Color fundus image:
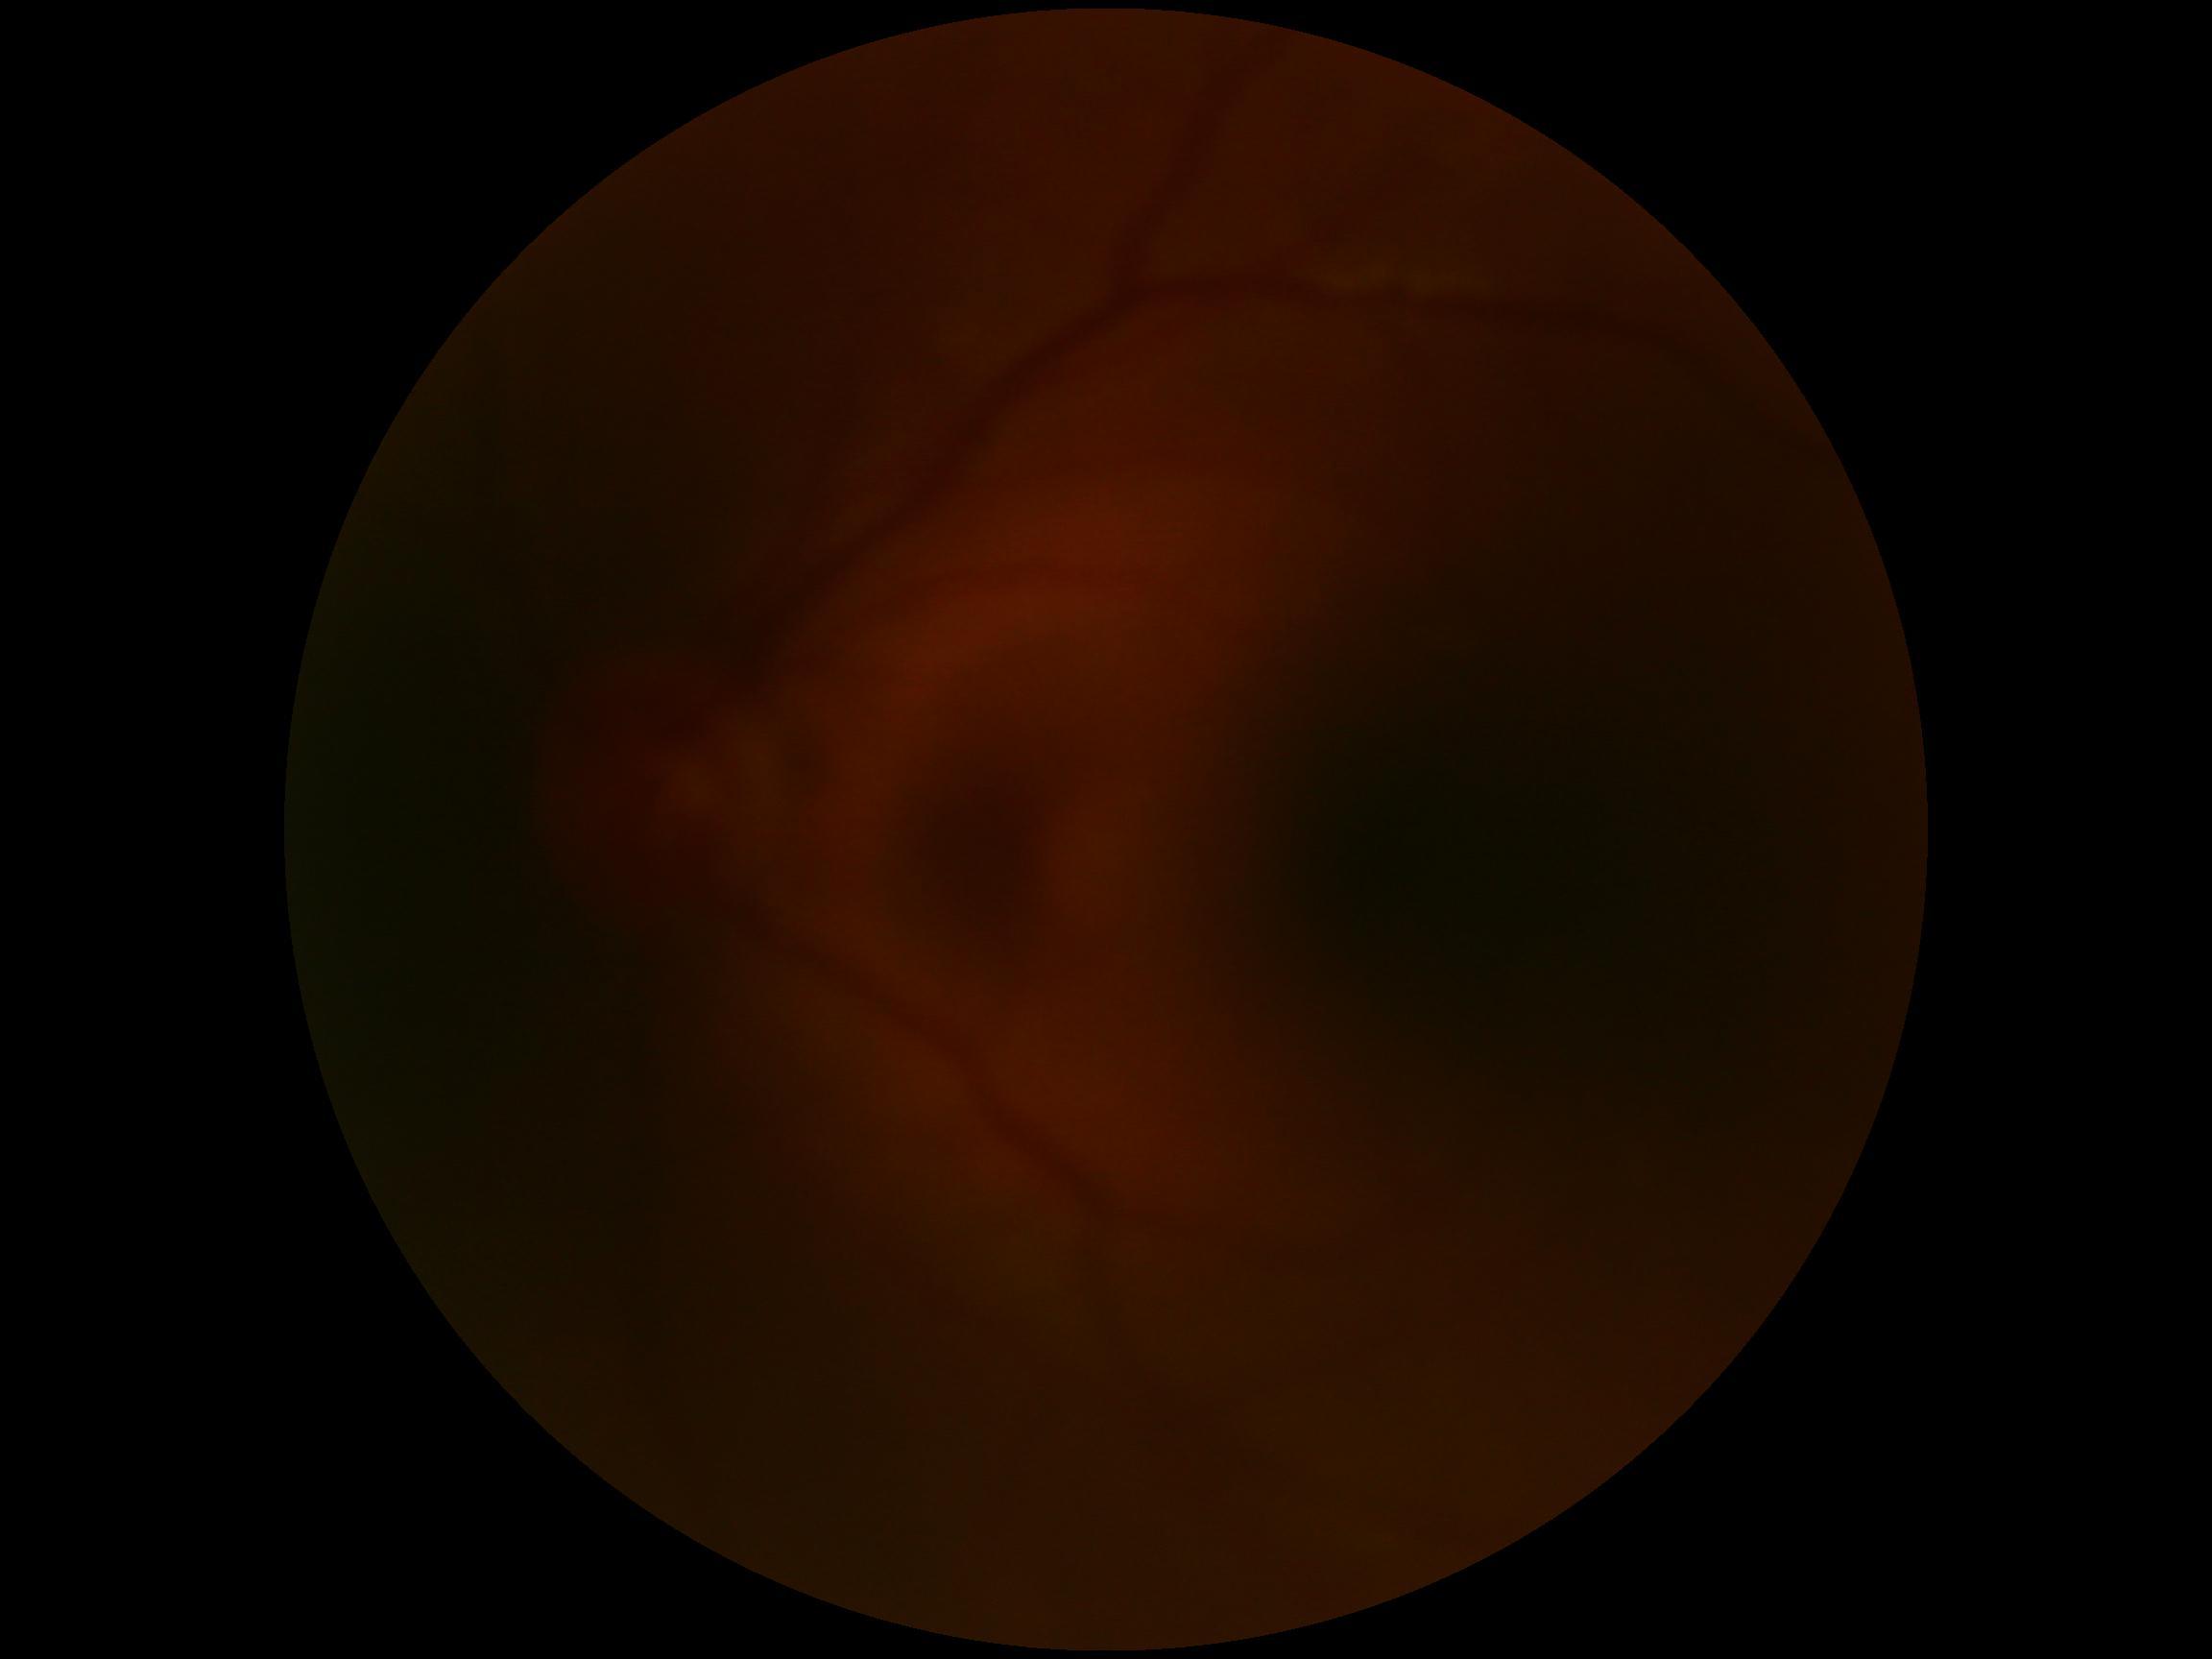
DR is ungradable.